UWF retinal mosaic
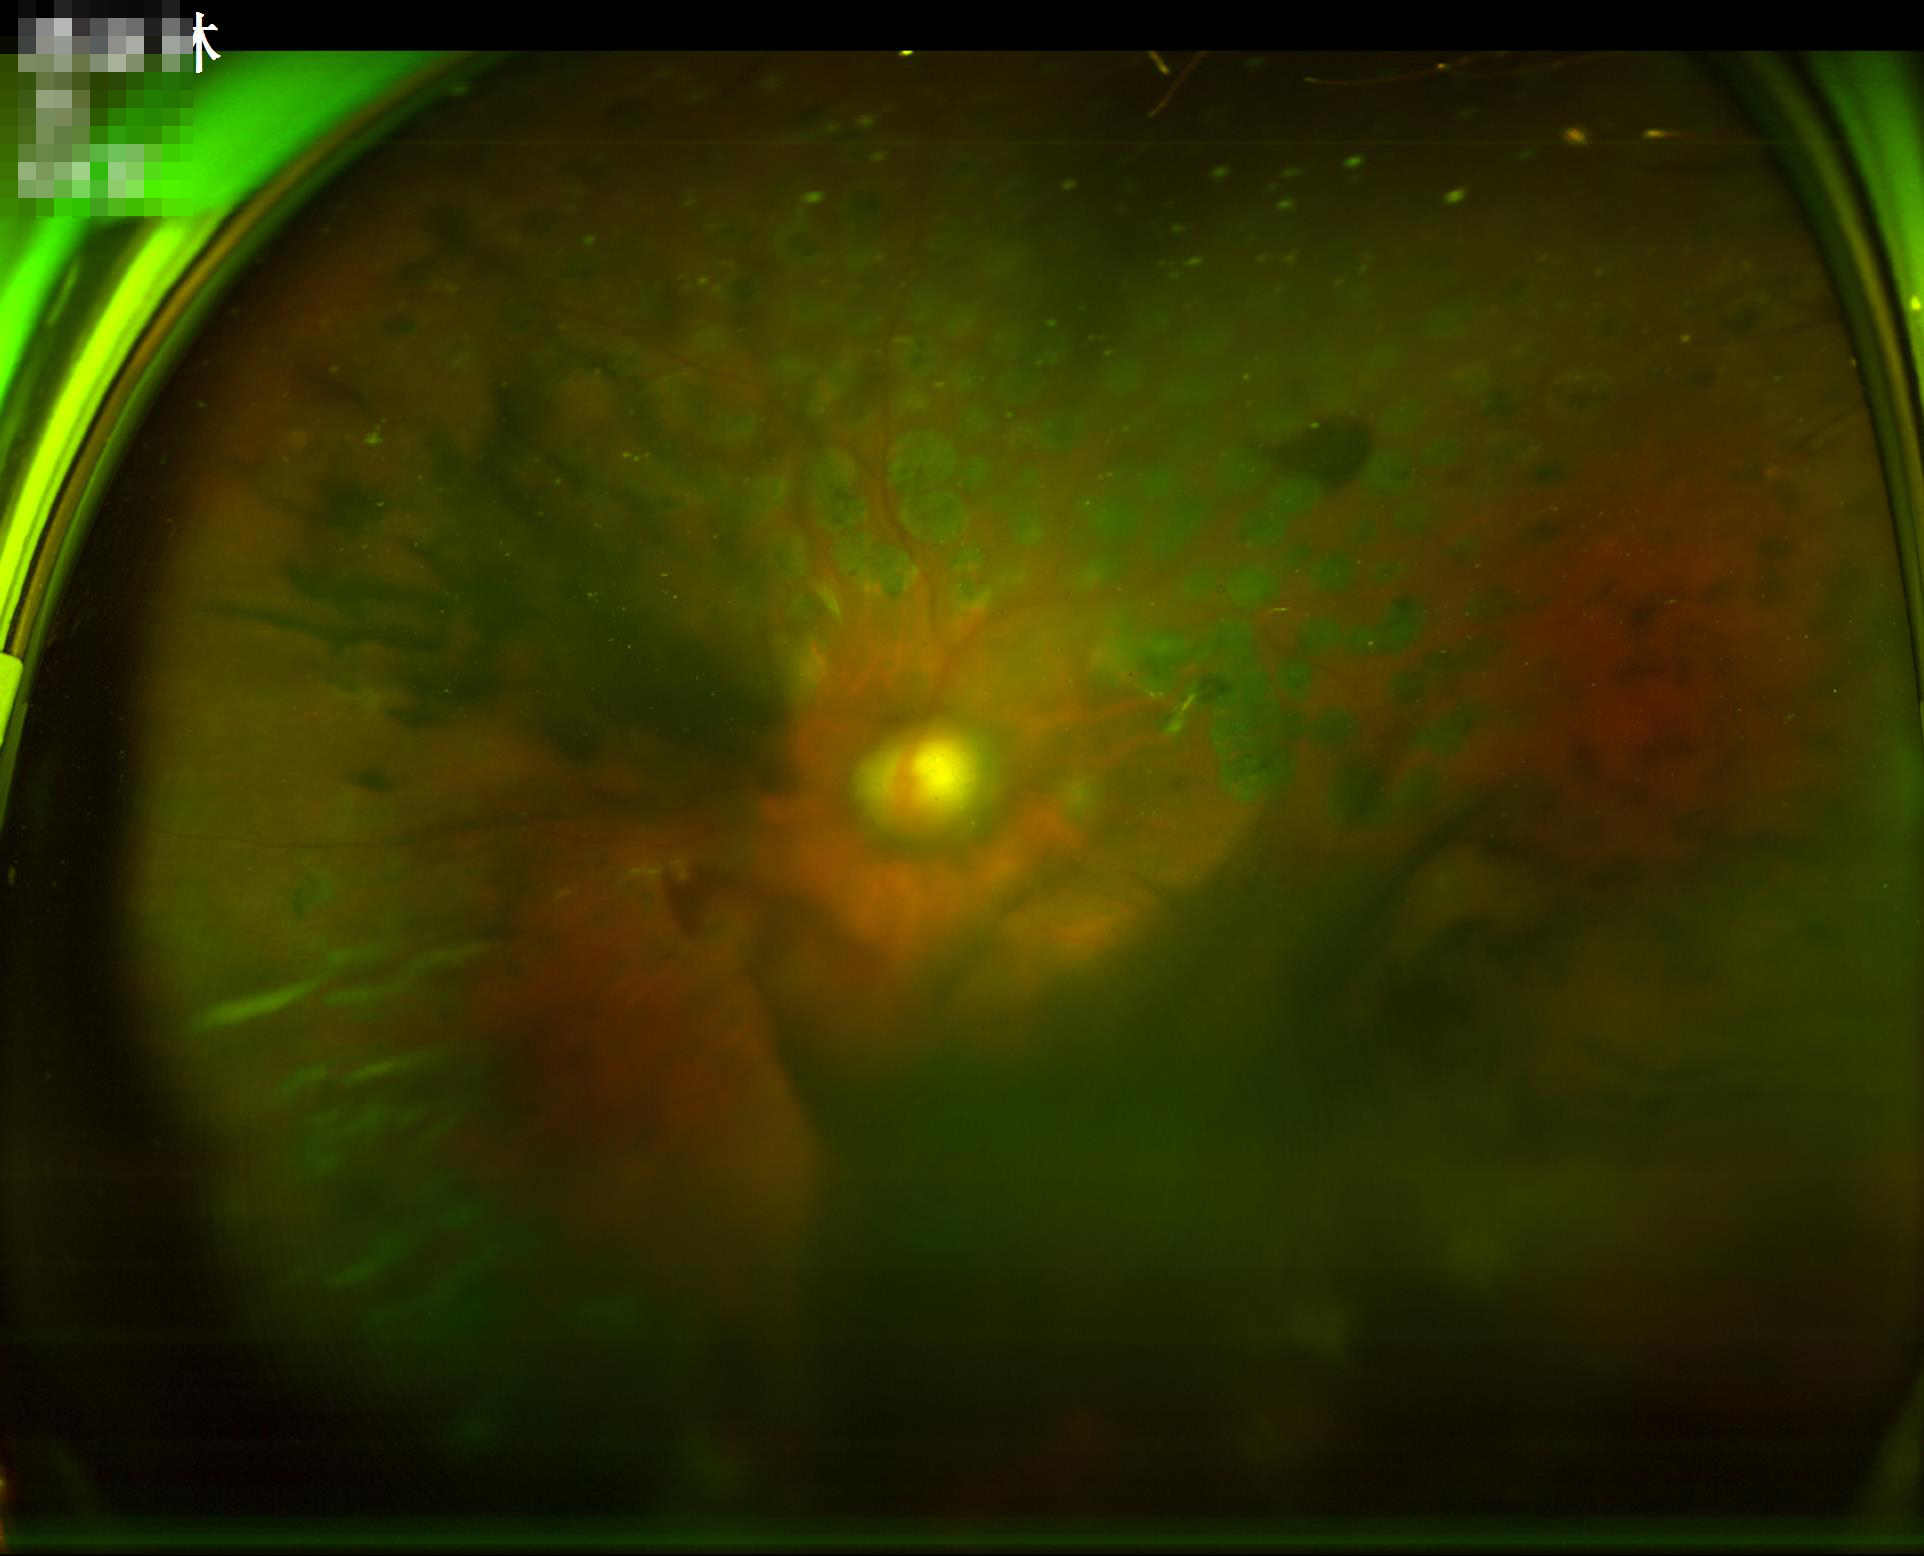

Quality grading:
- overall: suboptimal
- clarity: poor
- contrast: reduced
- illumination/color: poor